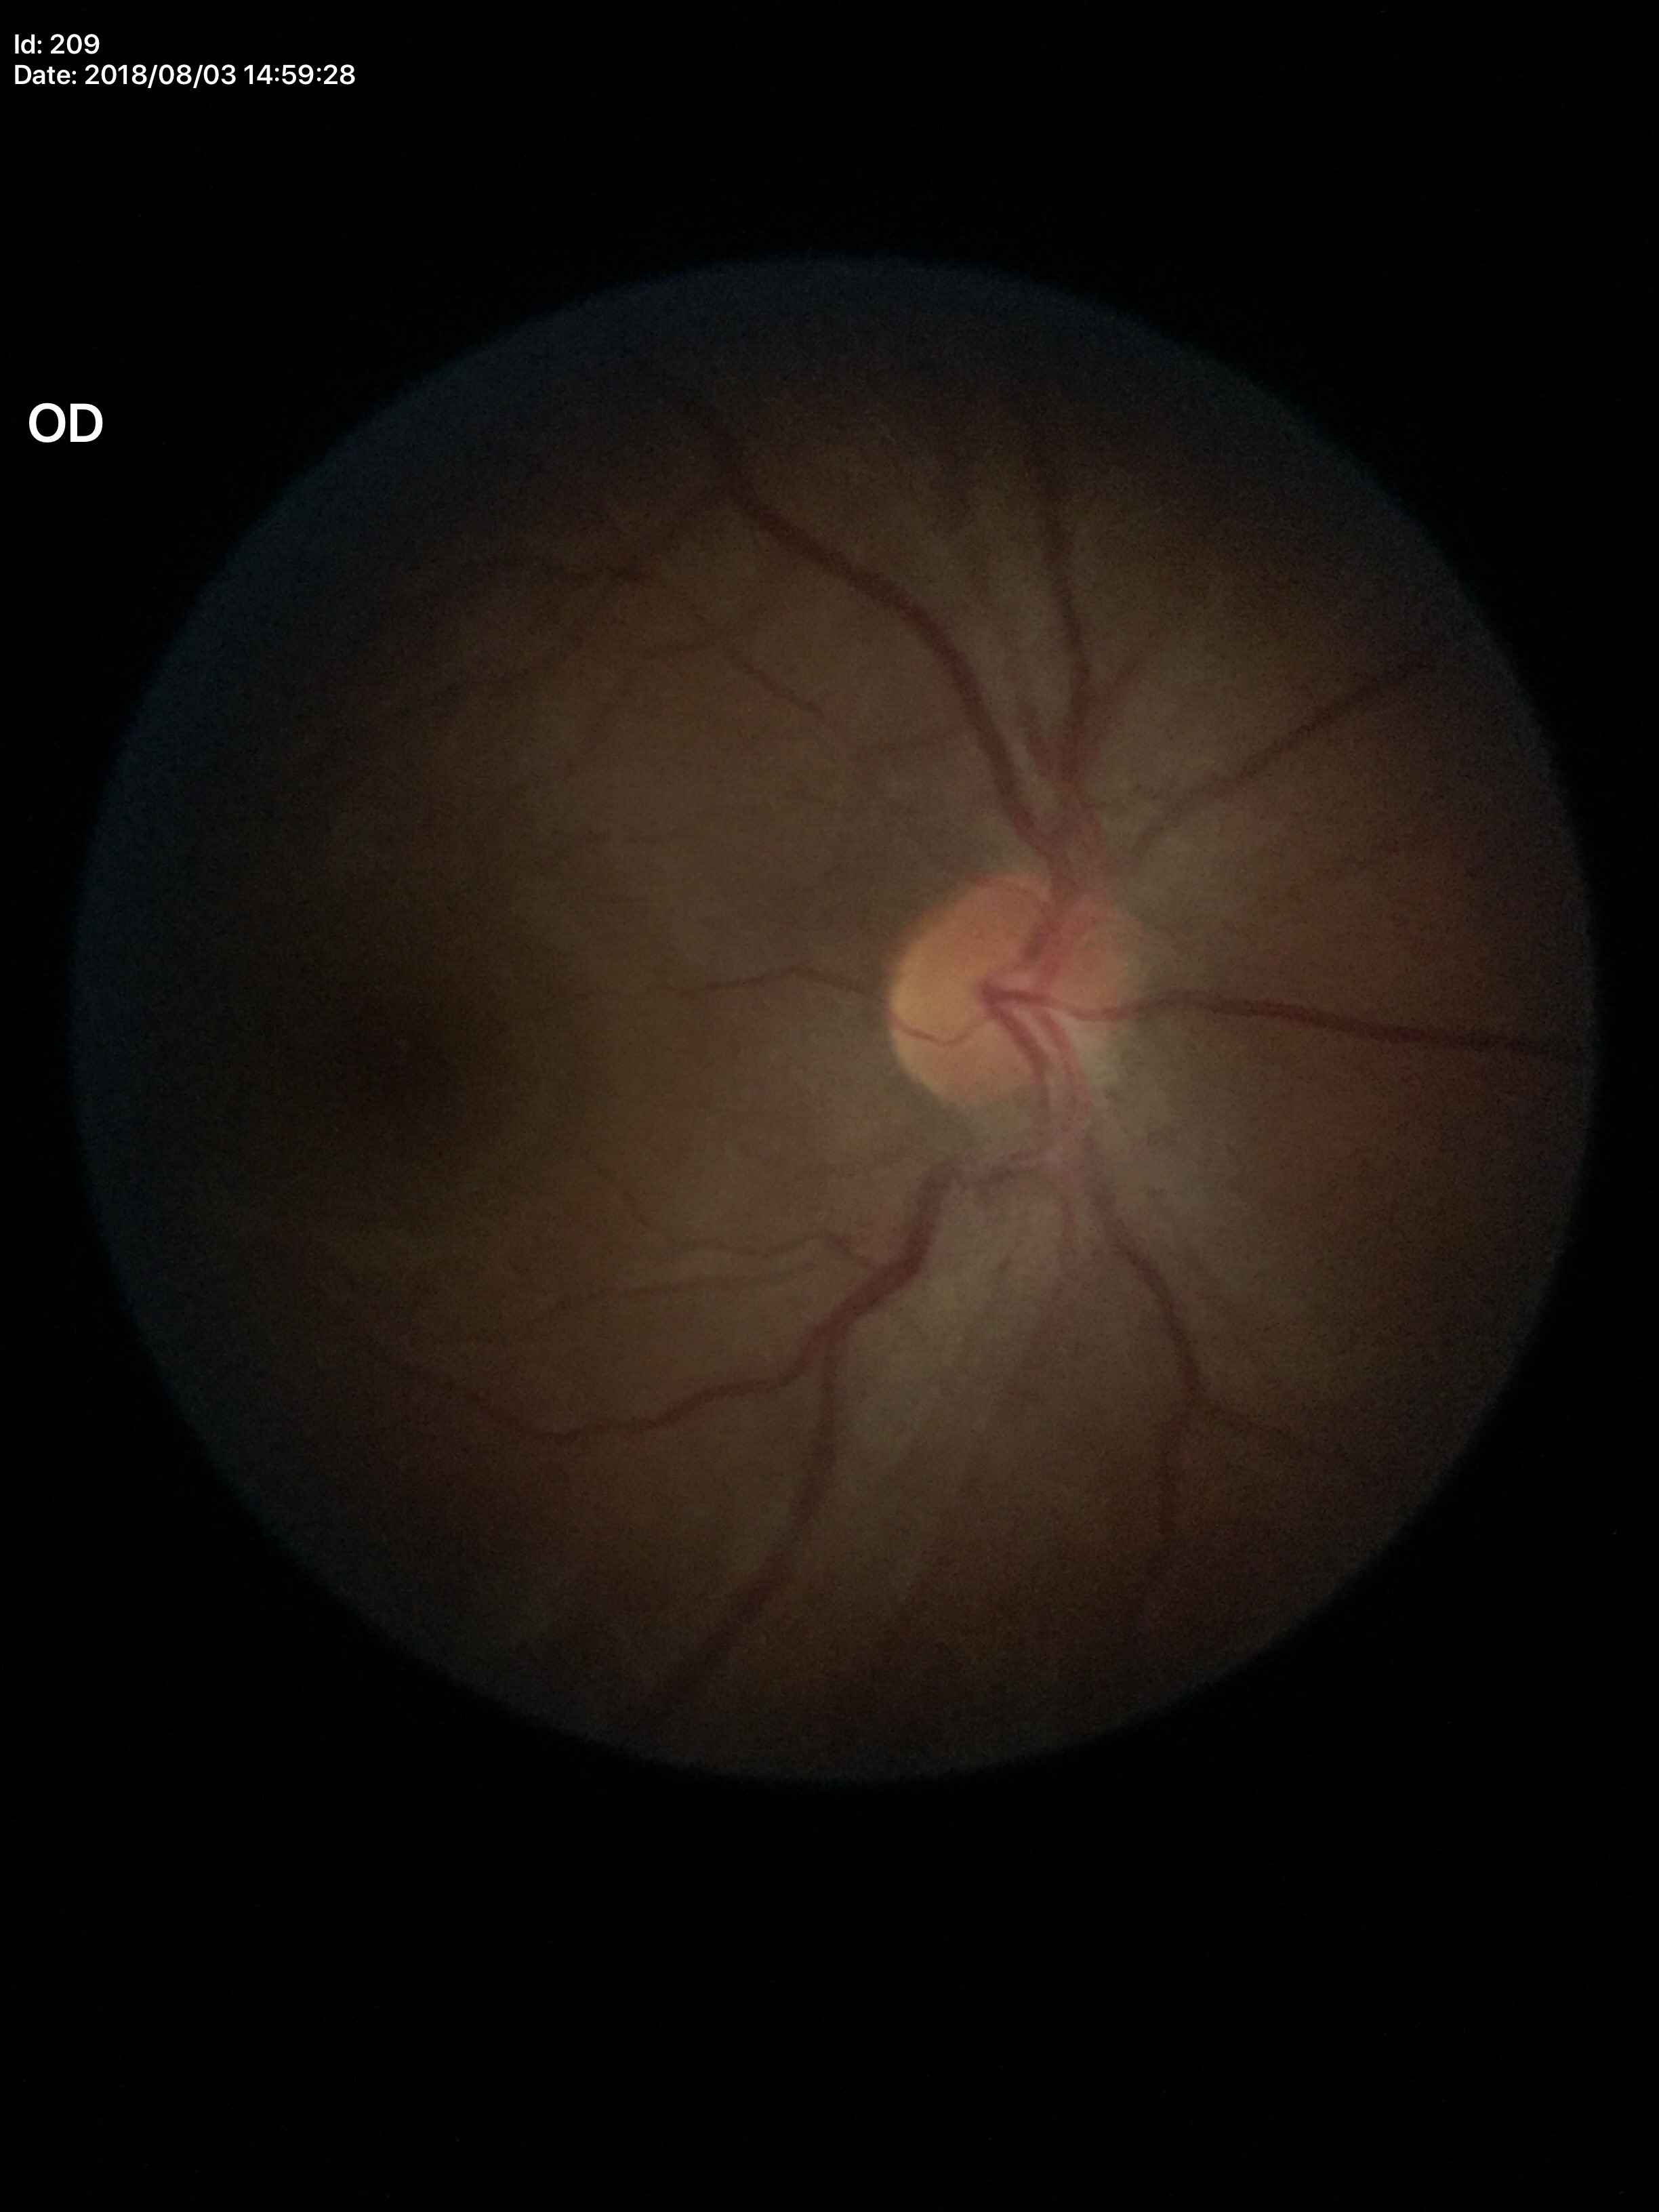

Glaucoma screening impression: negative (unanimous normal call).
Vertical cup-disc ratio: 0.38.